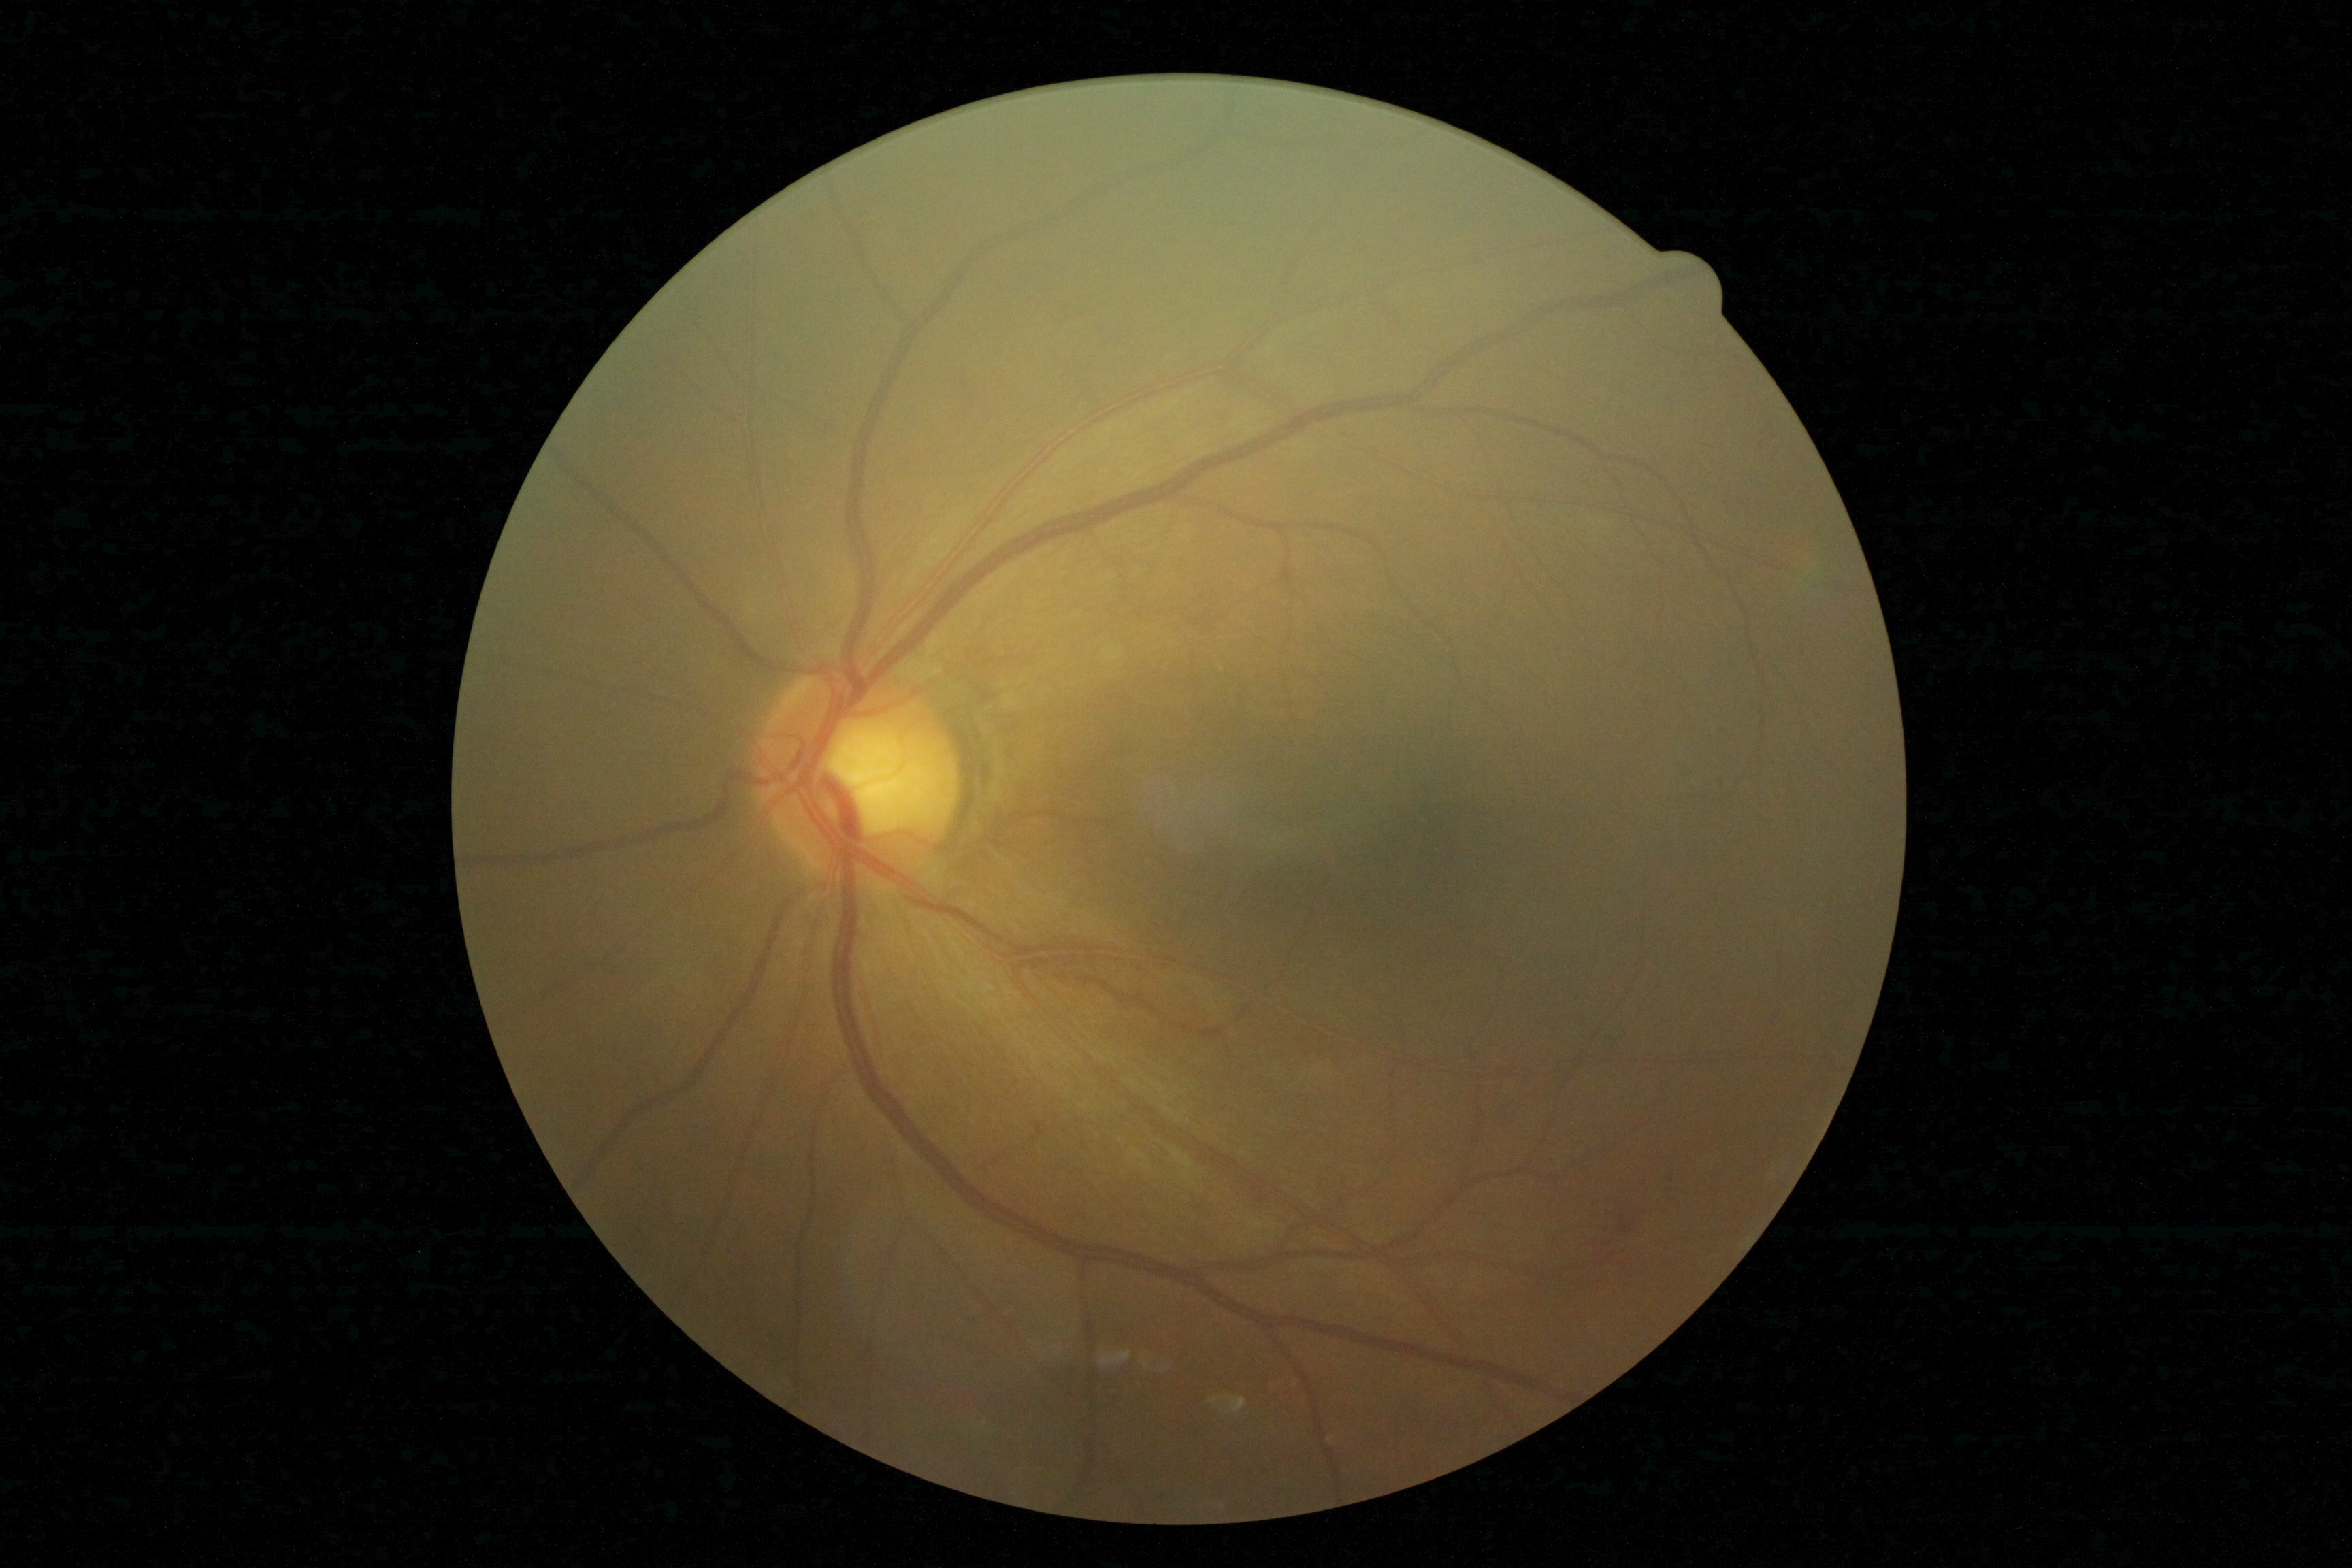

DR severity is moderate non-proliferative diabetic retinopathy (grade 2).